CFP, Remidio smartphone fundus camera:
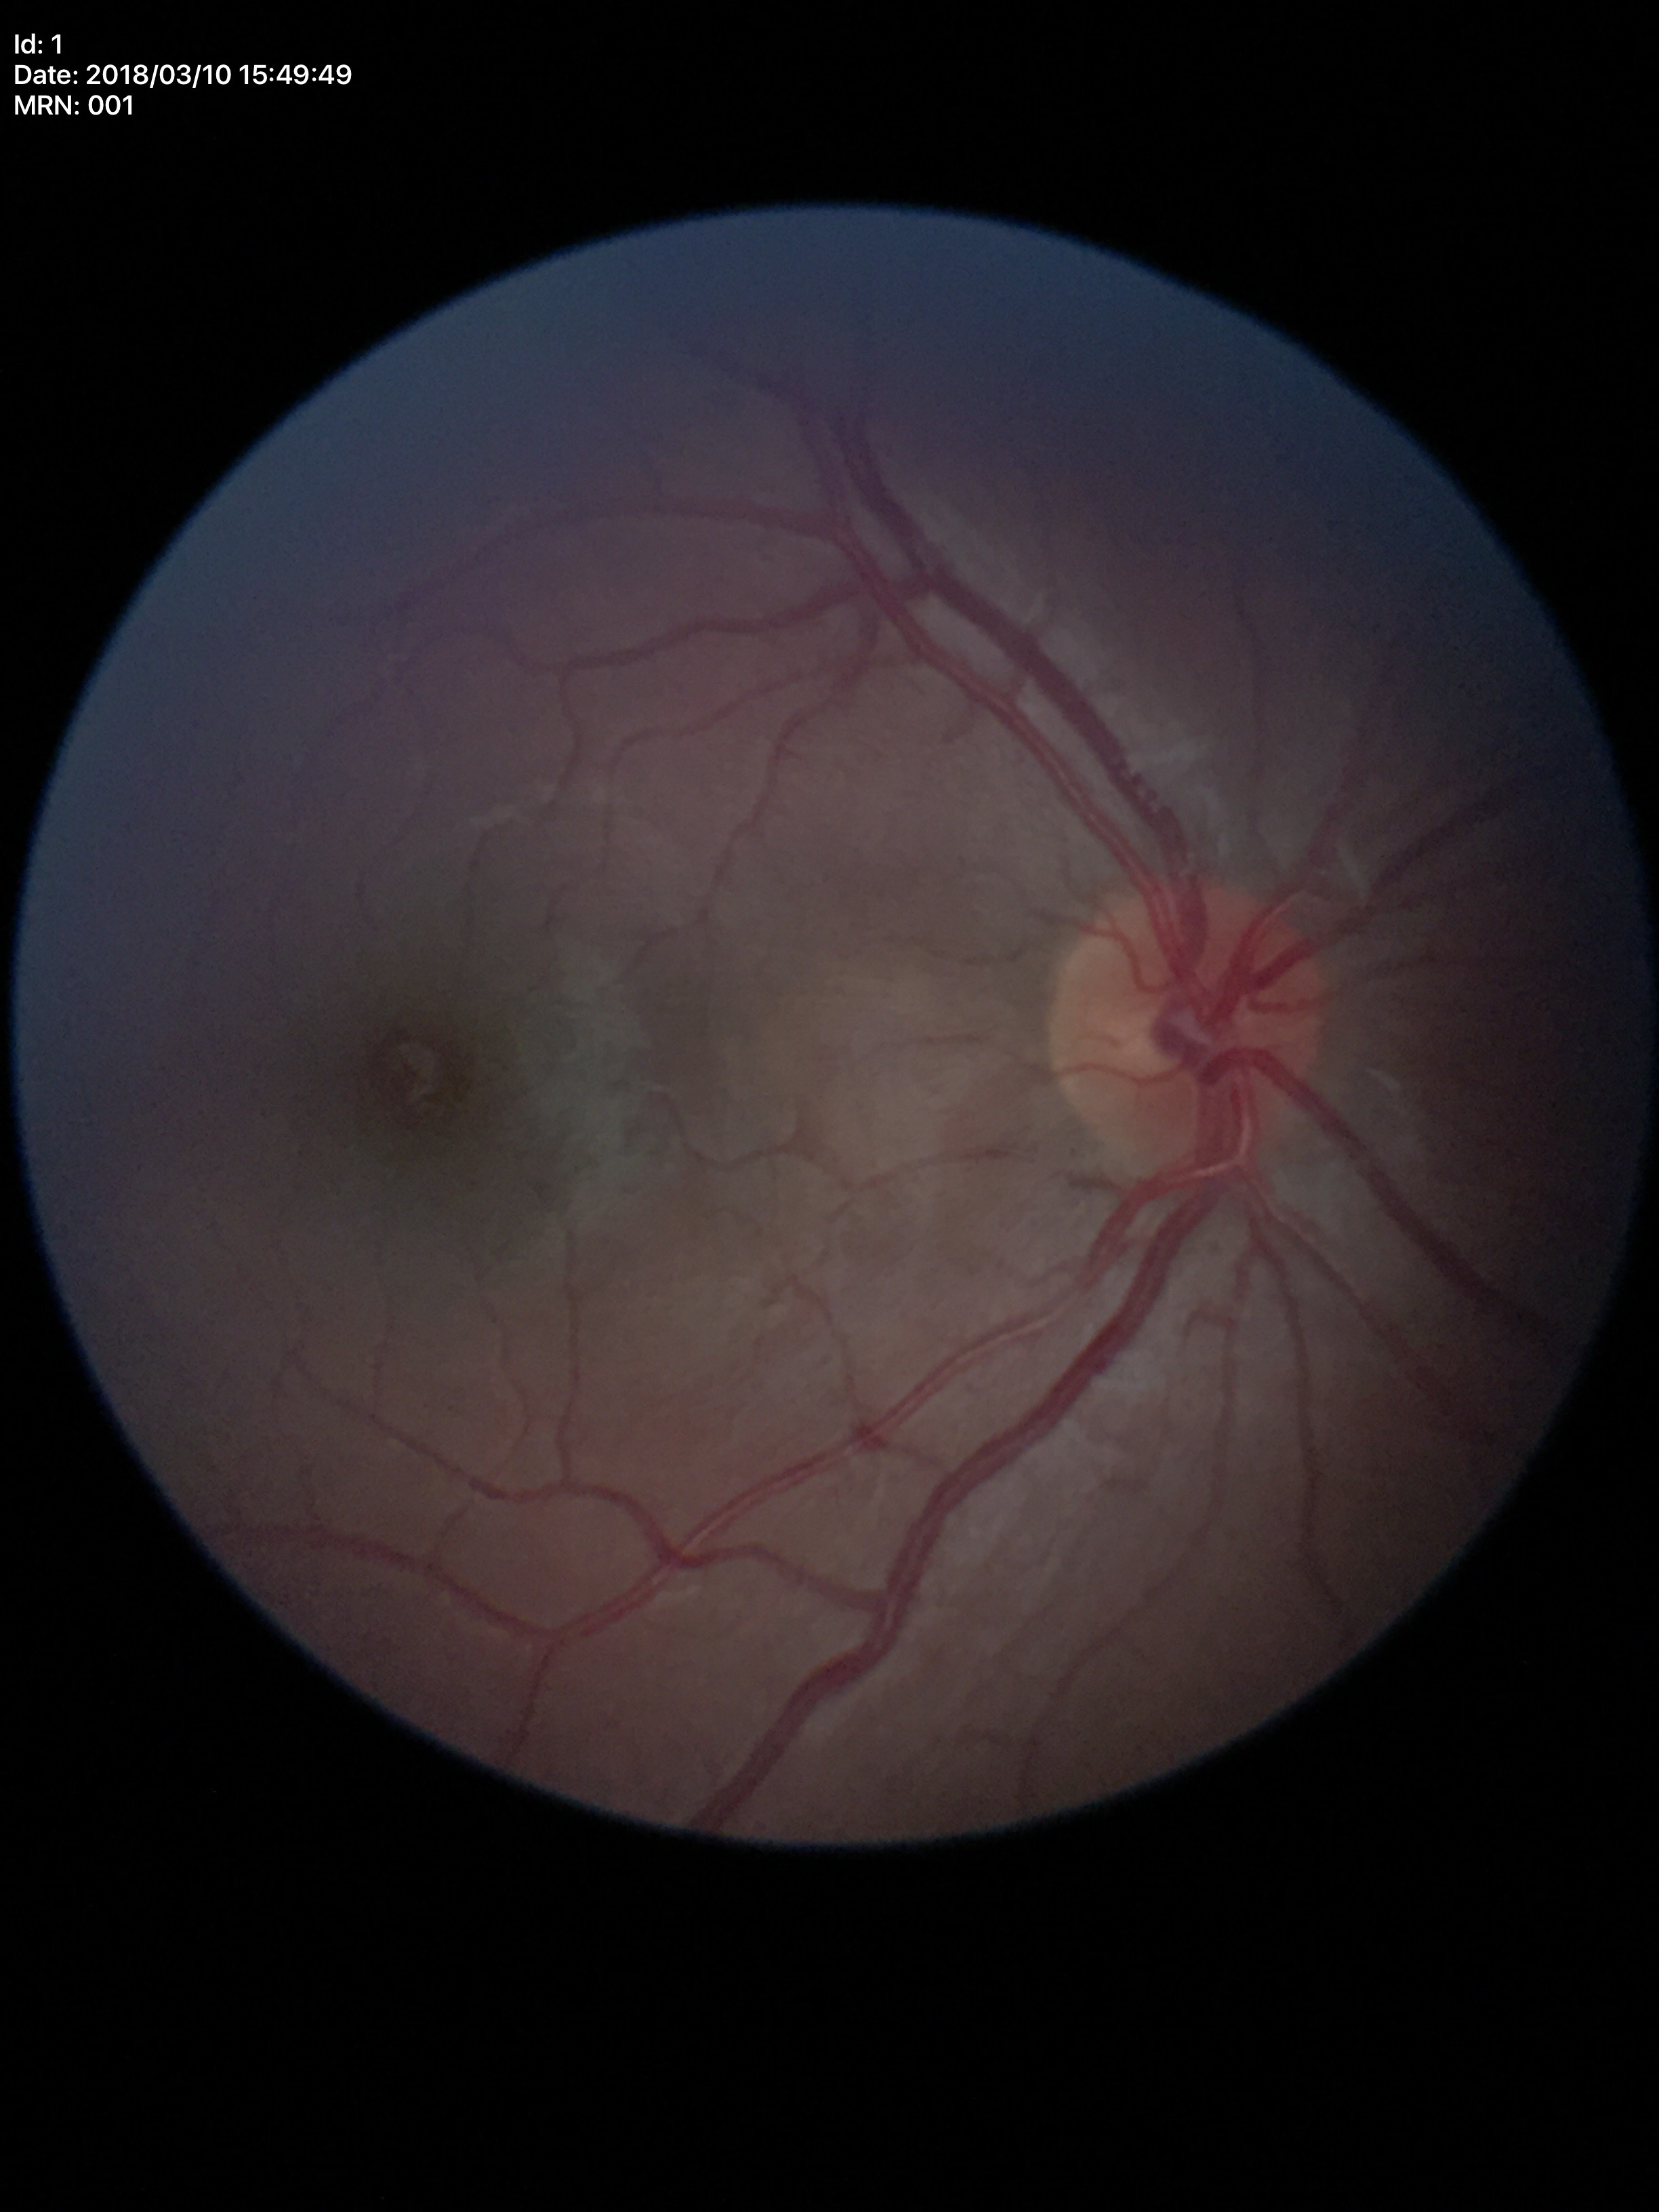

Not suspicious for glaucoma. Horizontal cup-to-disc ratio (HCDR) of 0.46. Vertical cup-to-disc ratio (VCDR) of 0.42.